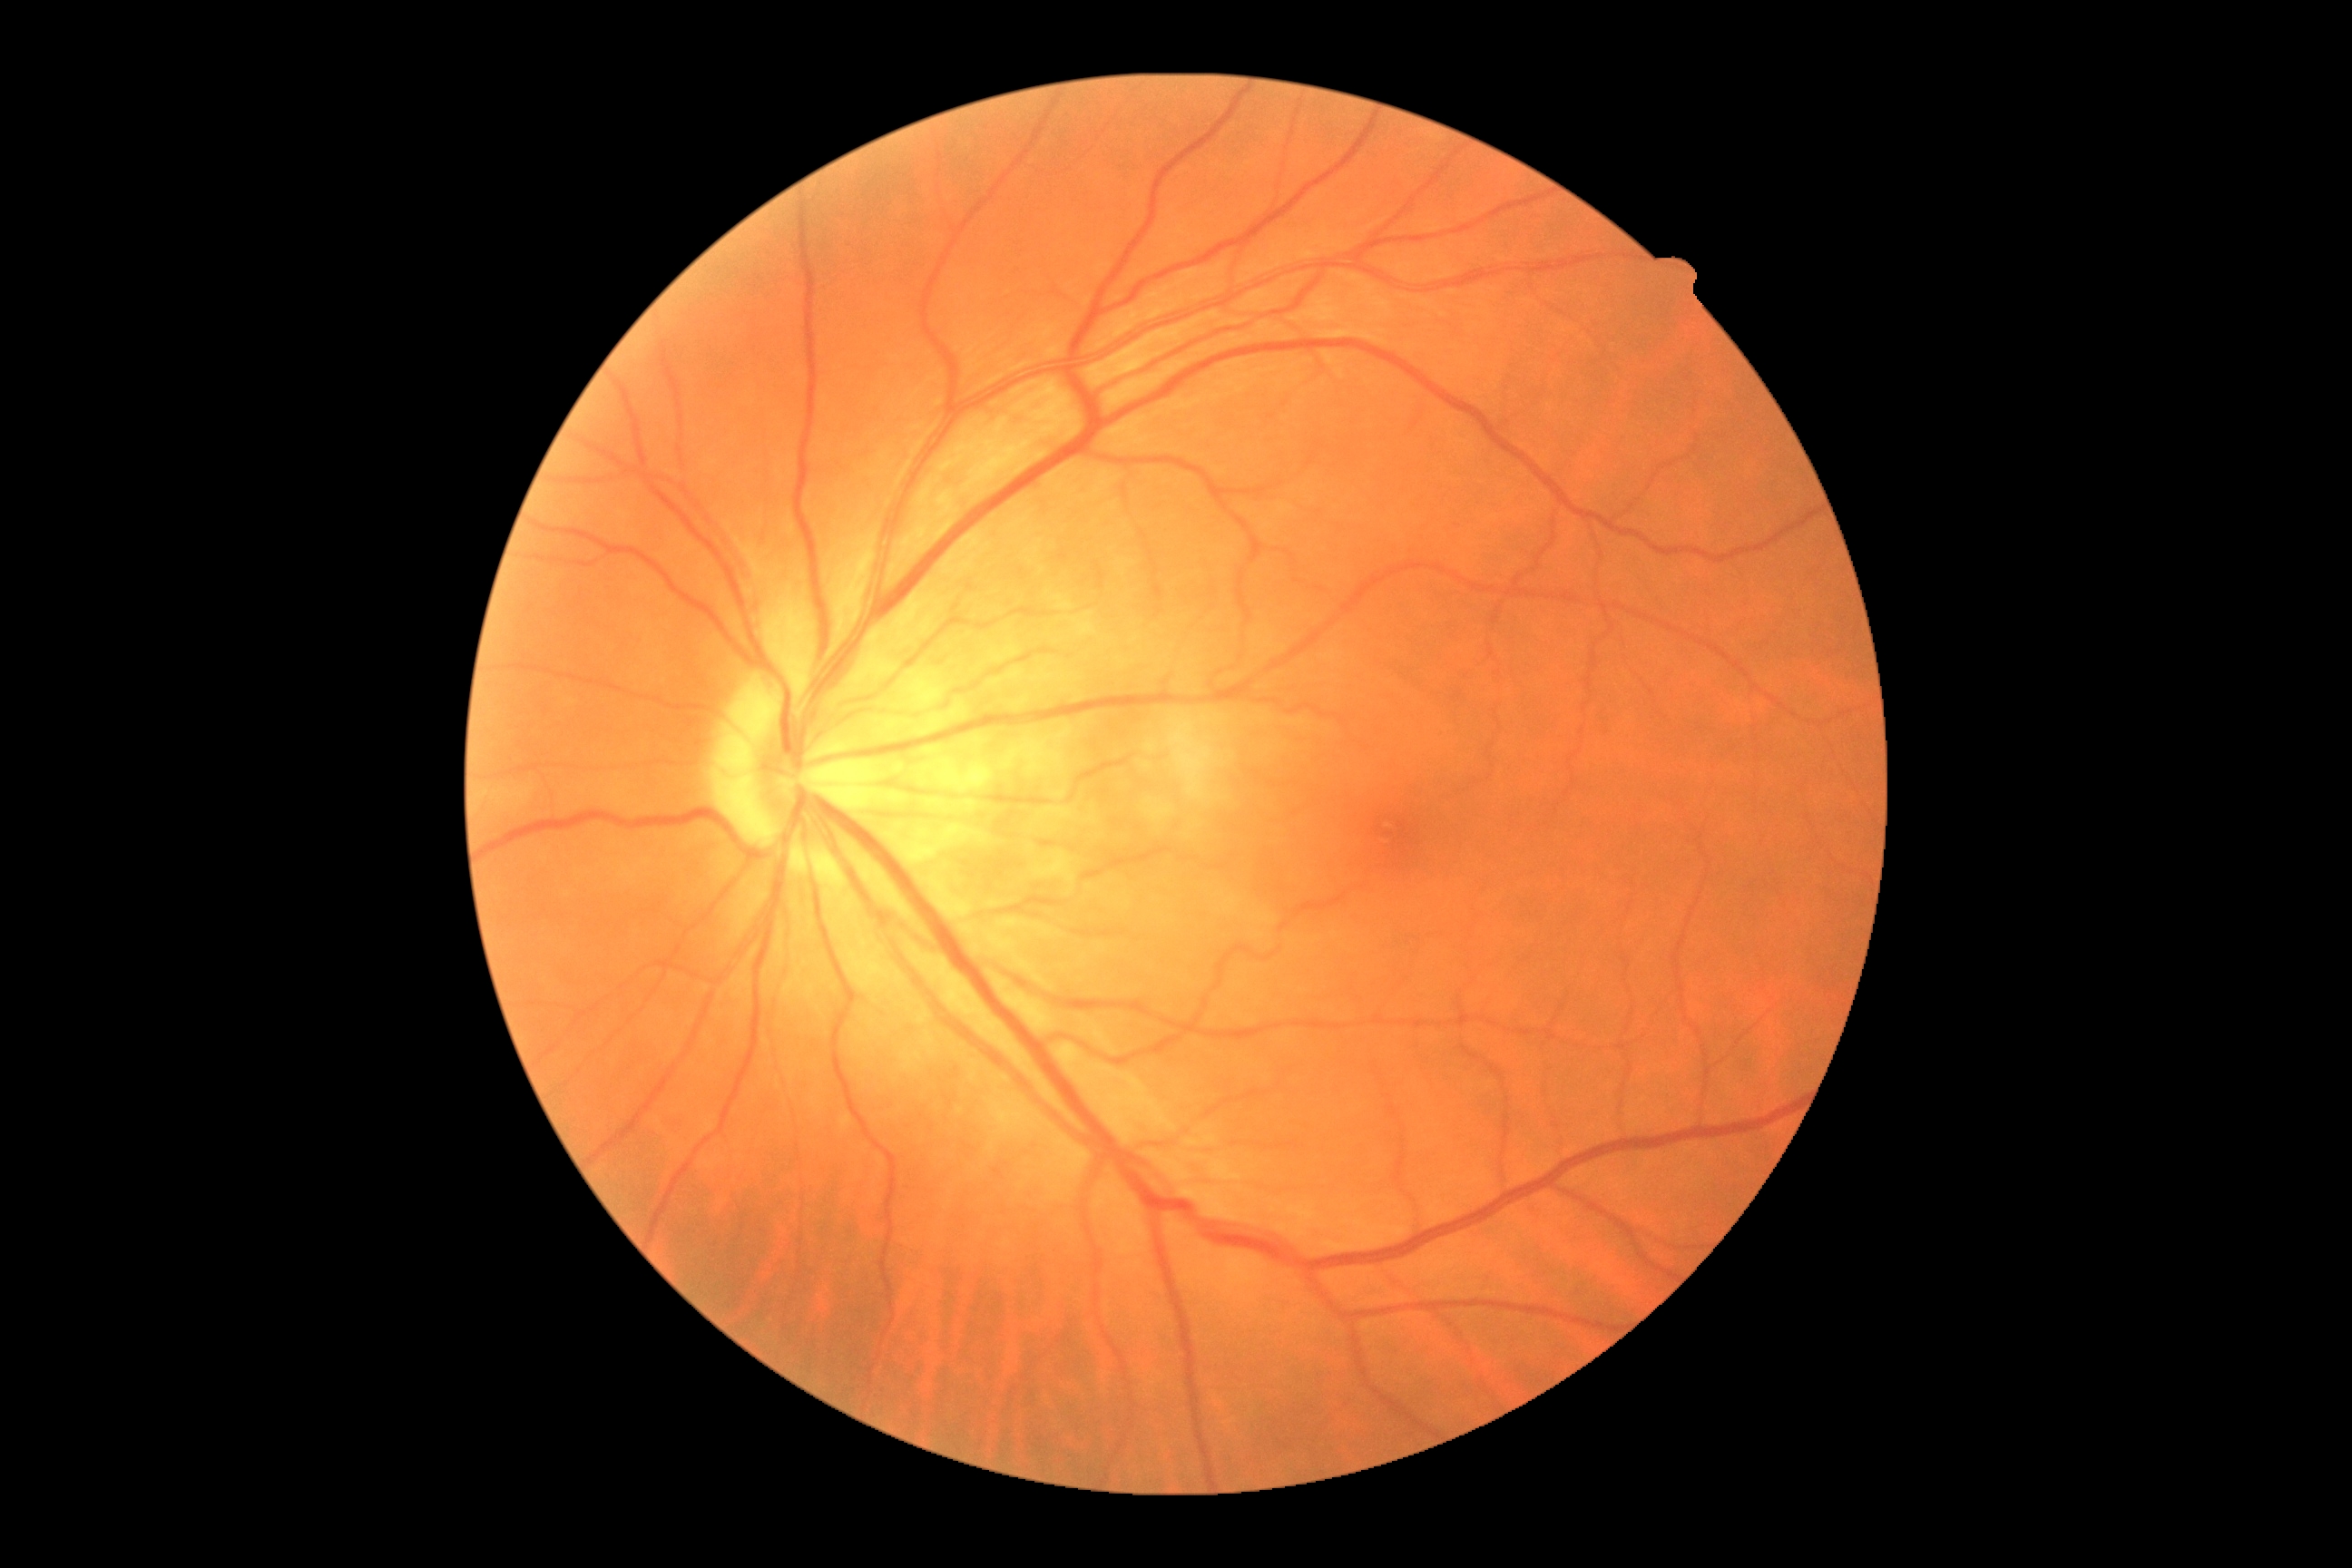
Annotations:
• diabetic retinopathy (DR): grade 0 (no apparent retinopathy)